45° FOV · image size 2352x1568 · color fundus photograph — 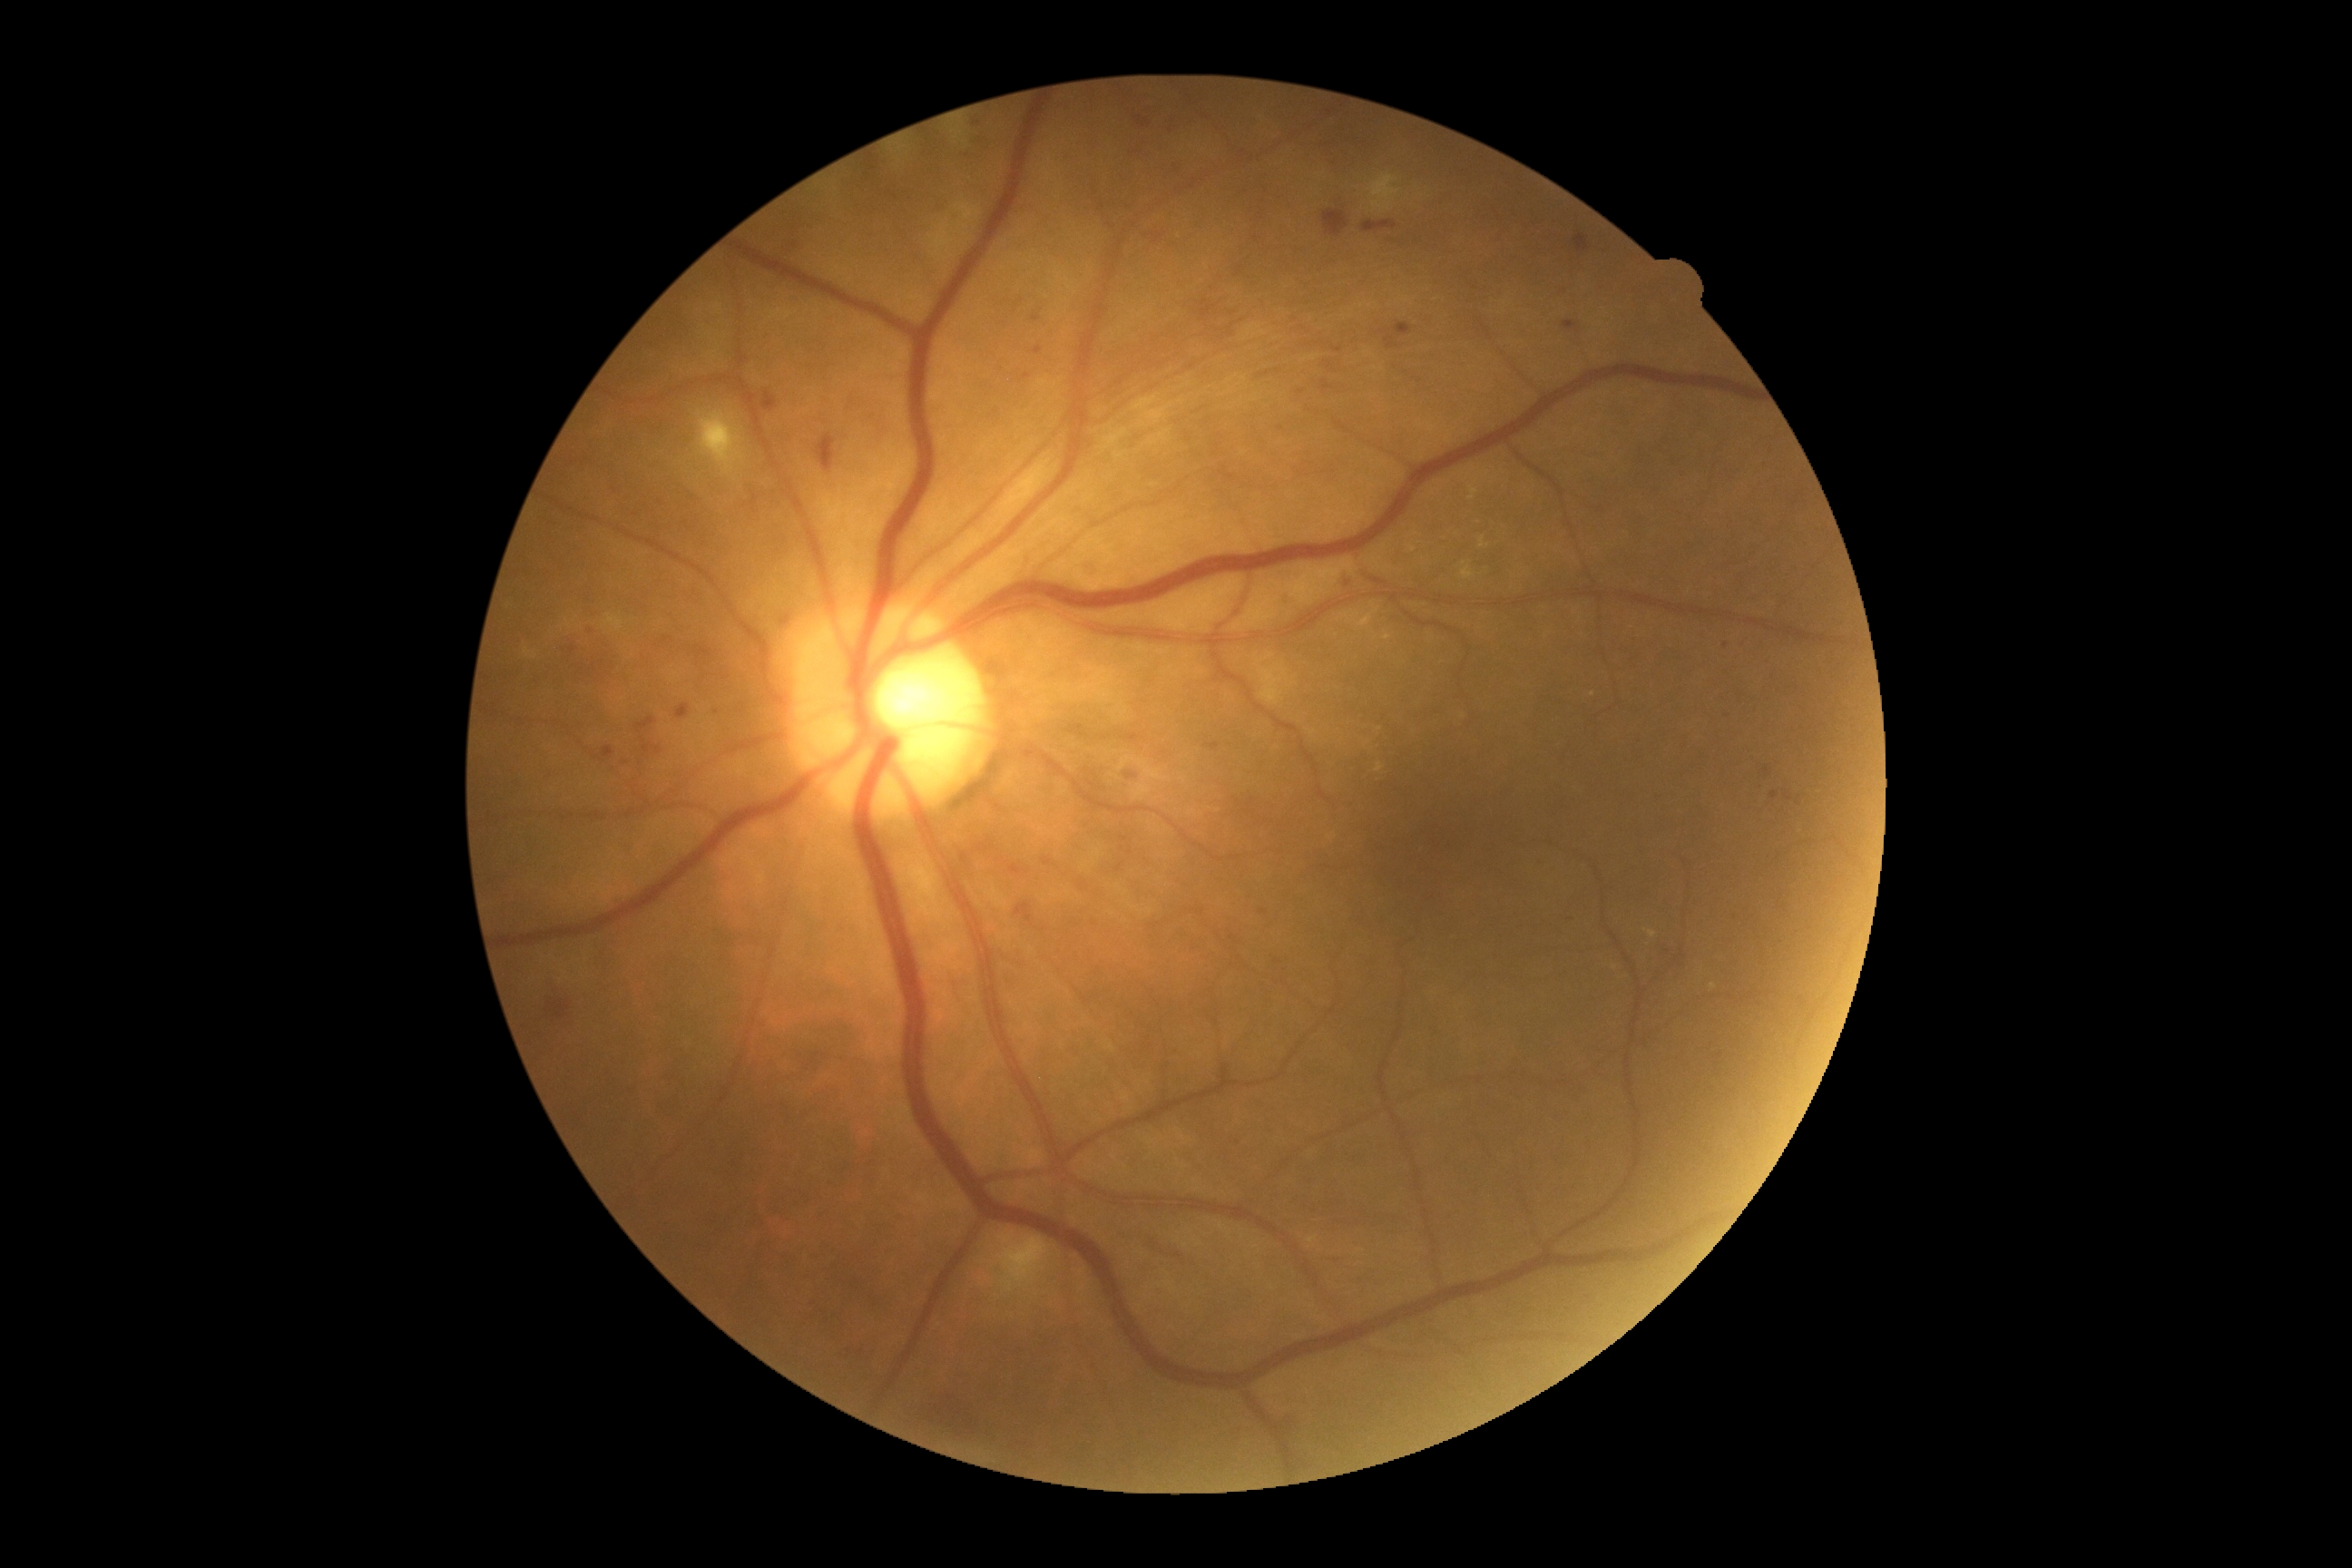
The retinopathy is classified as non-proliferative diabetic retinopathy.
DR stage: 2/4.